2212x1659 · CFP
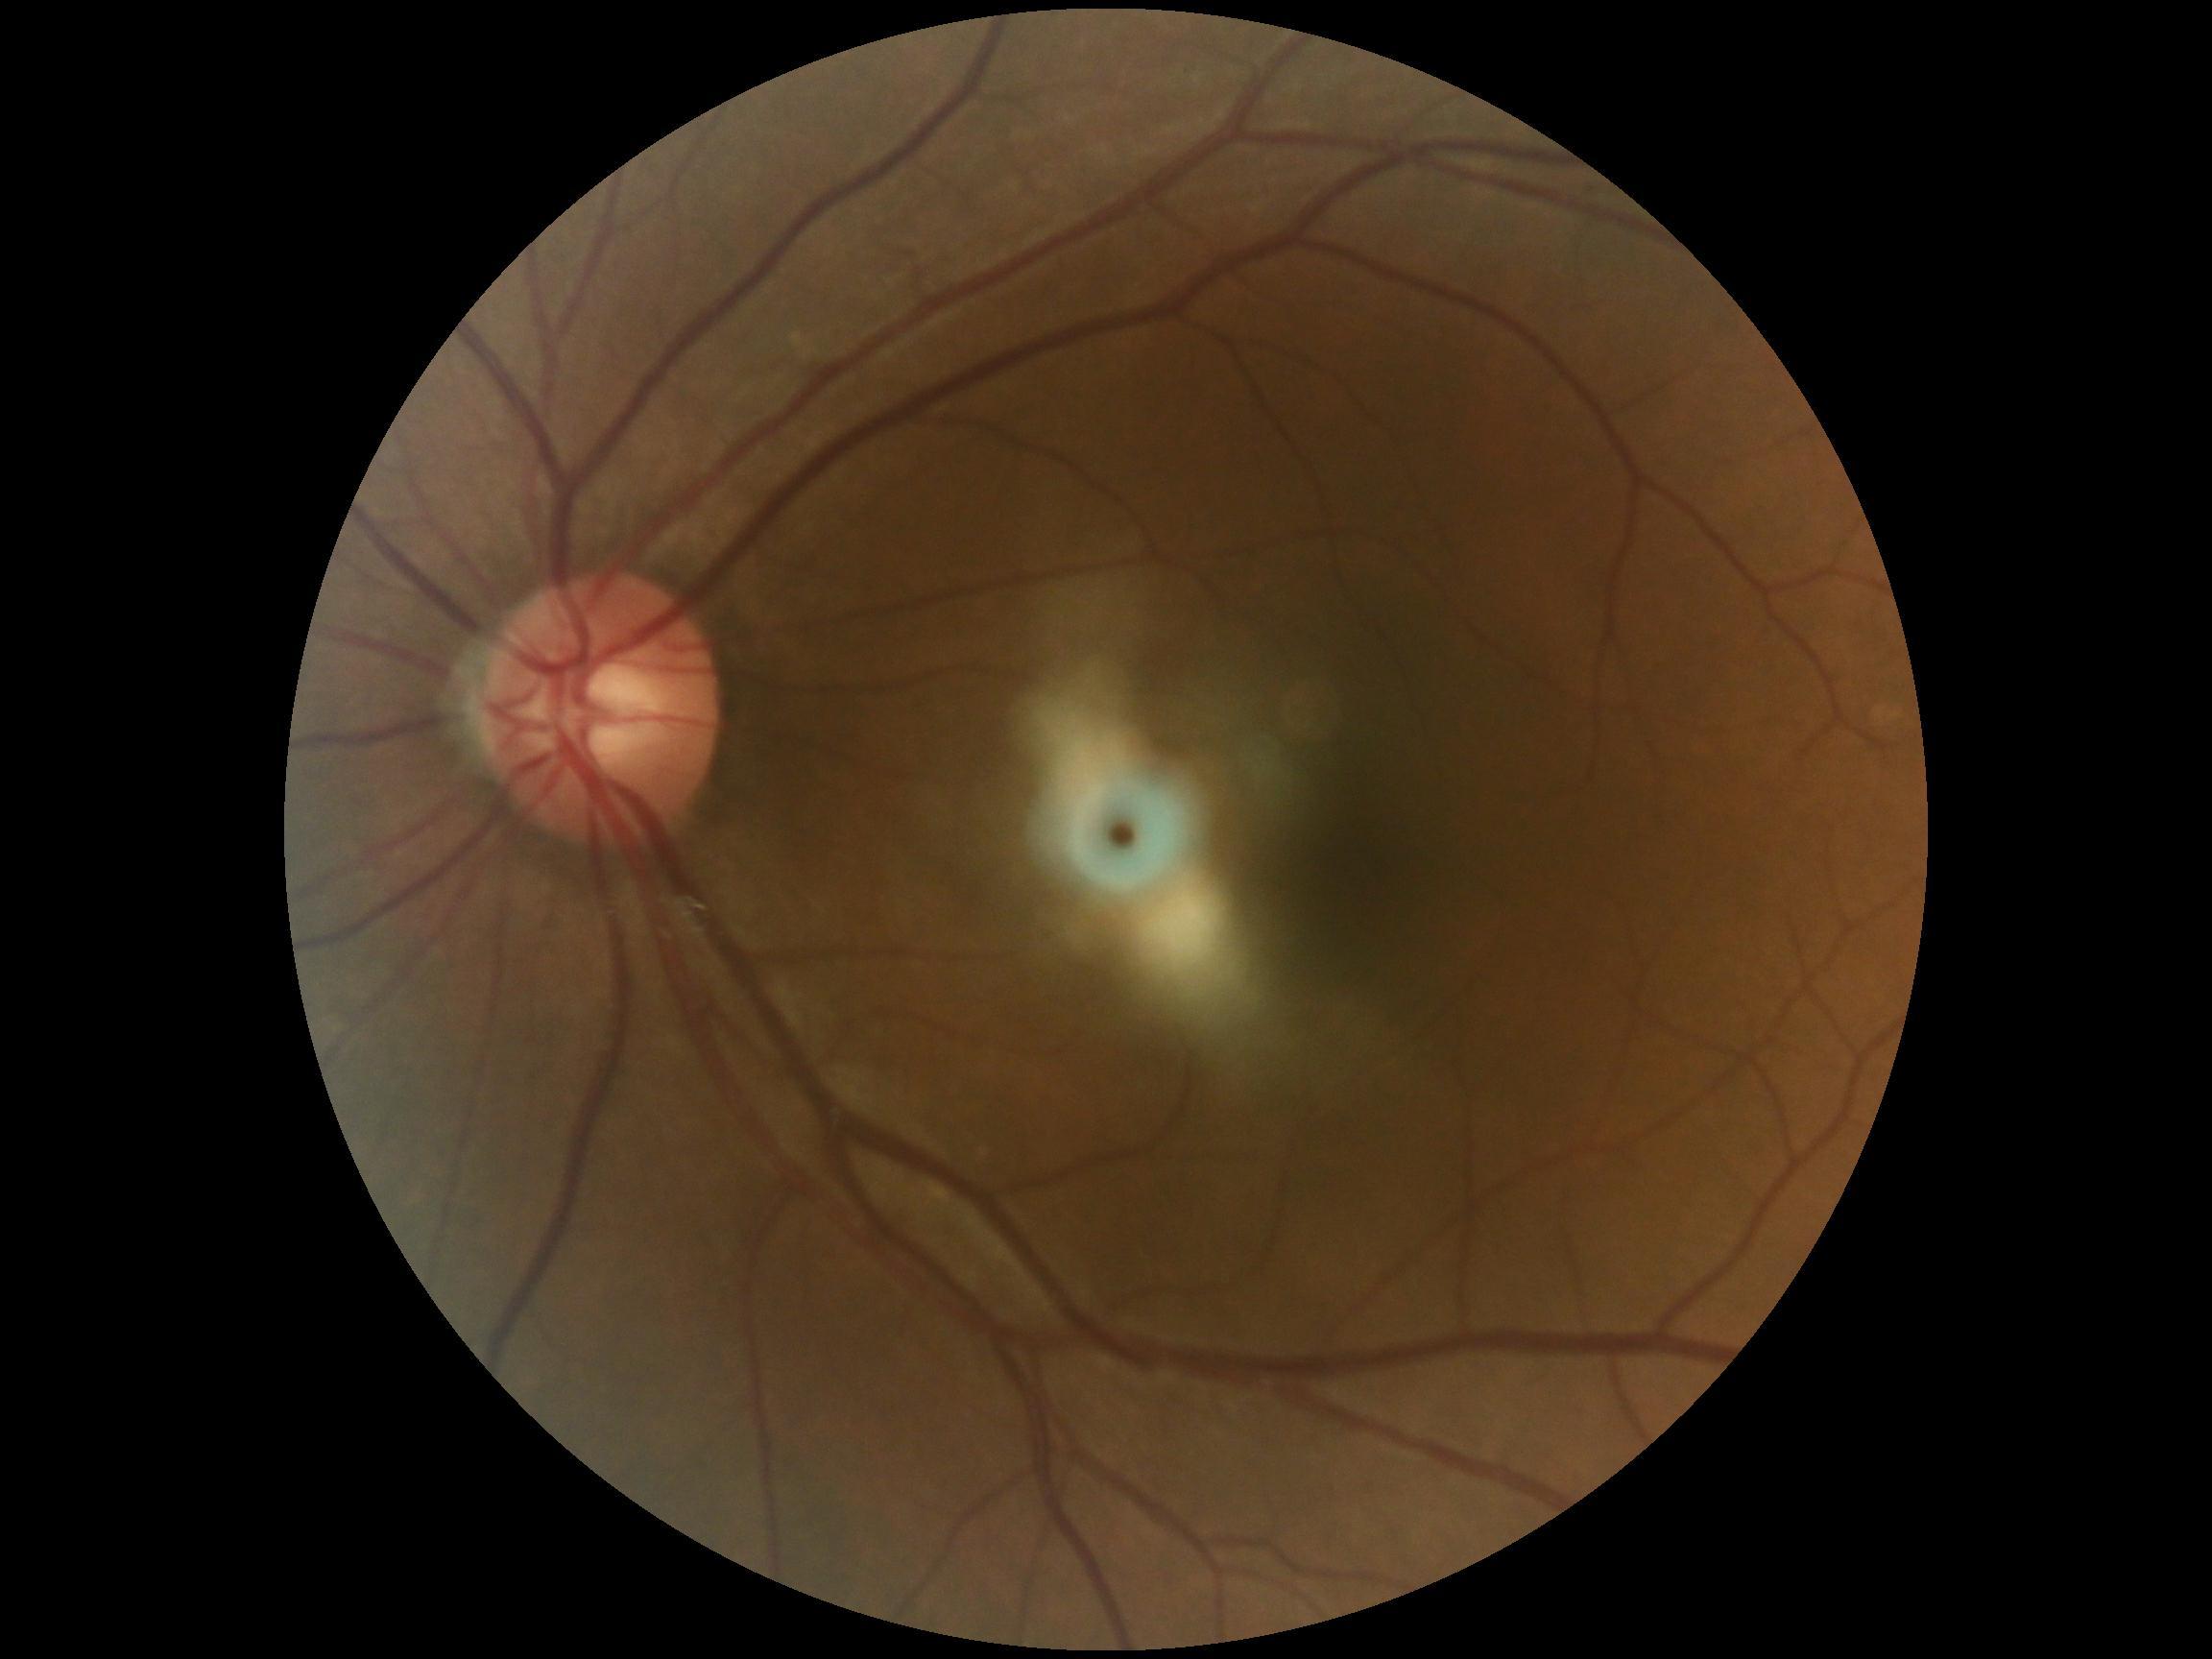 DR impression: no DR findings, retinopathy grade: 0 (no apparent retinopathy).